Pediatric wide-field fundus photograph.
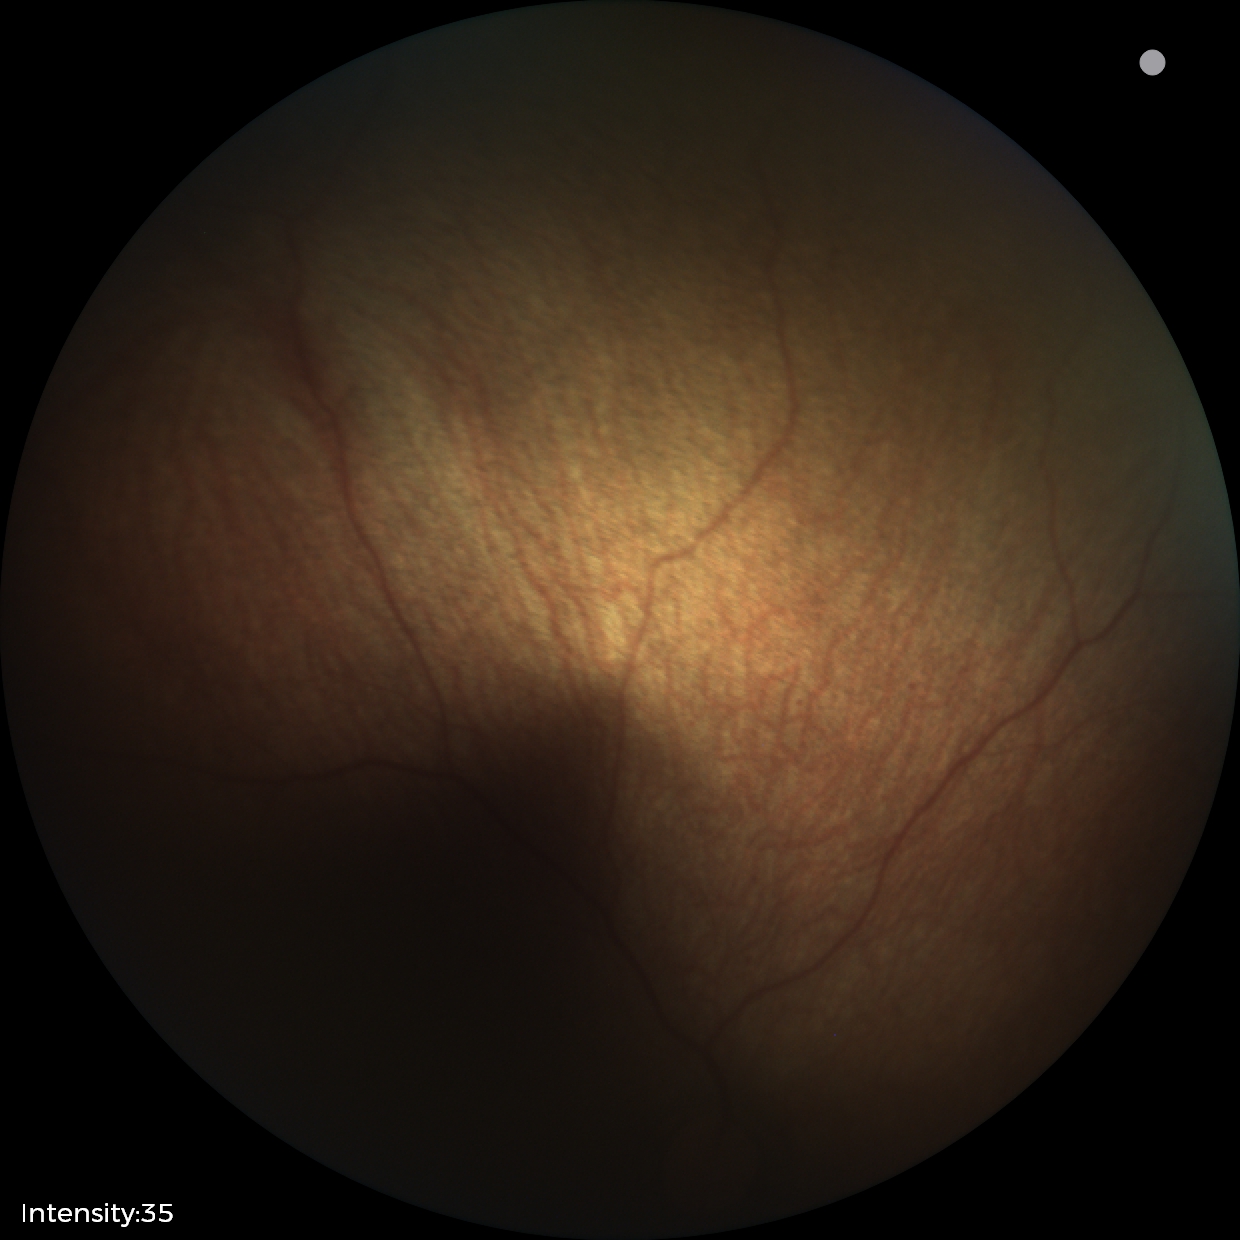 Screening examination diagnosed as physiological.